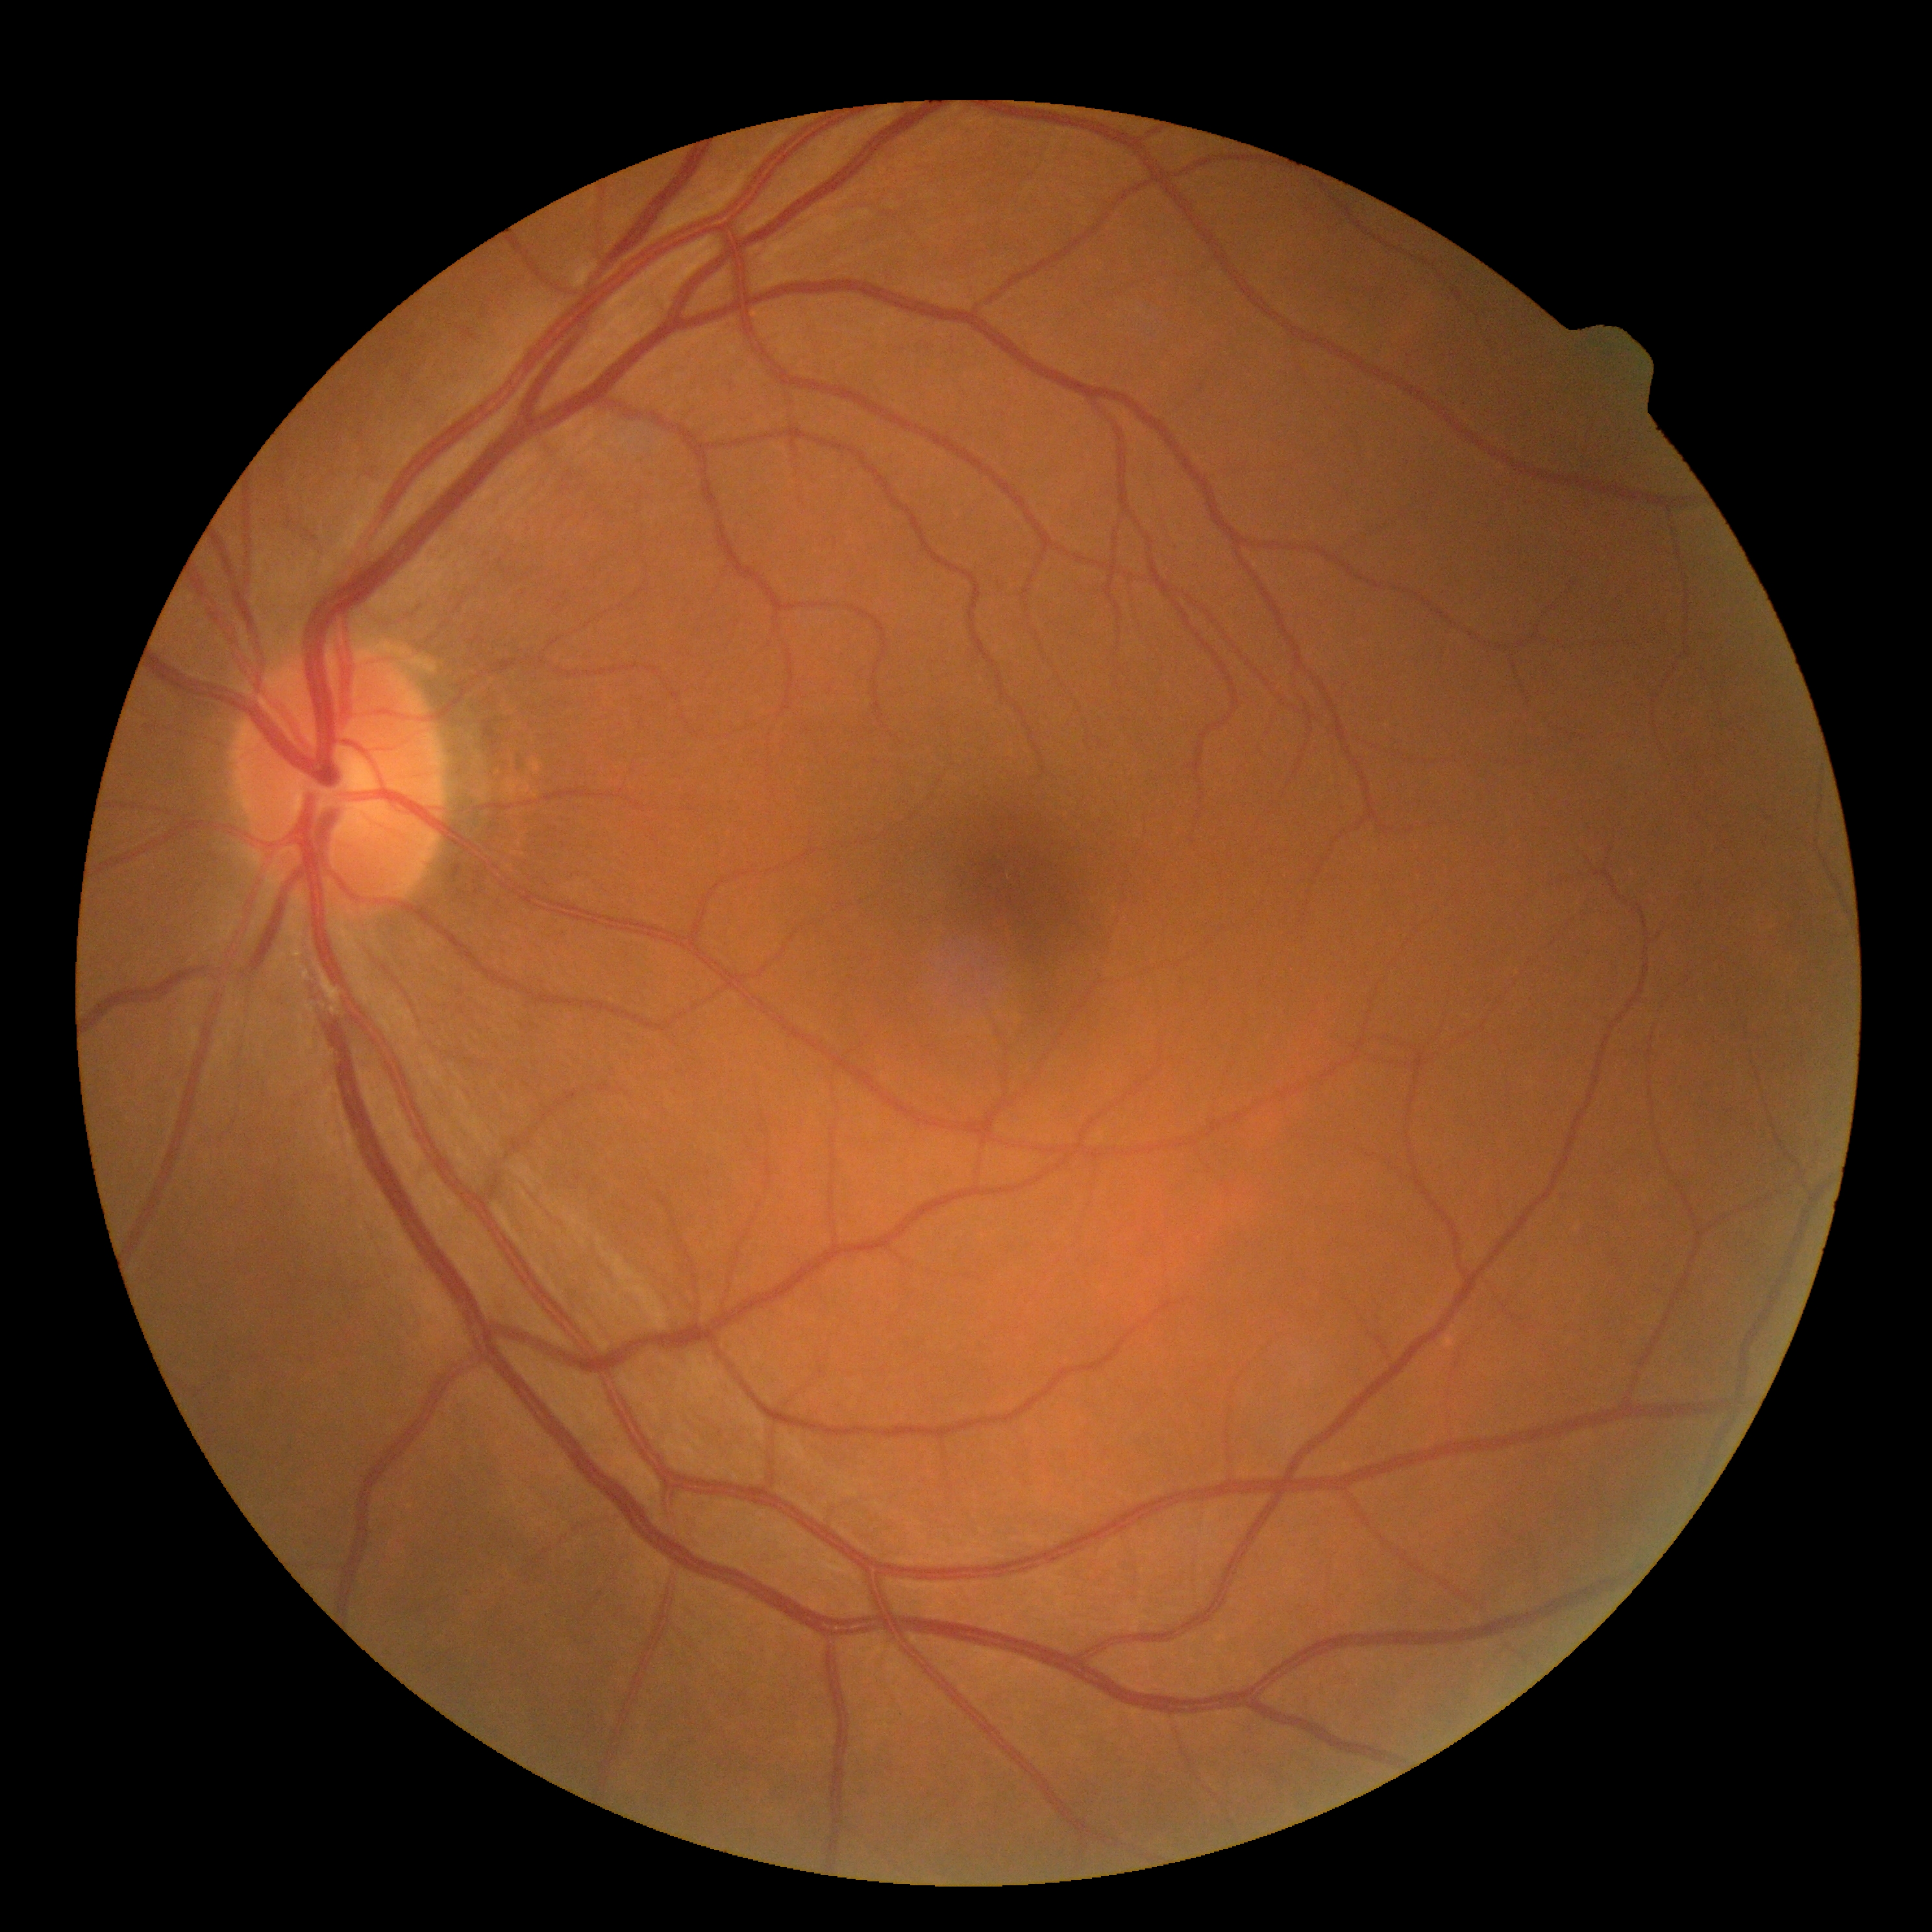 Diabetic retinopathy severity is 0.